Fundus photo taken with a portable handheld camera:
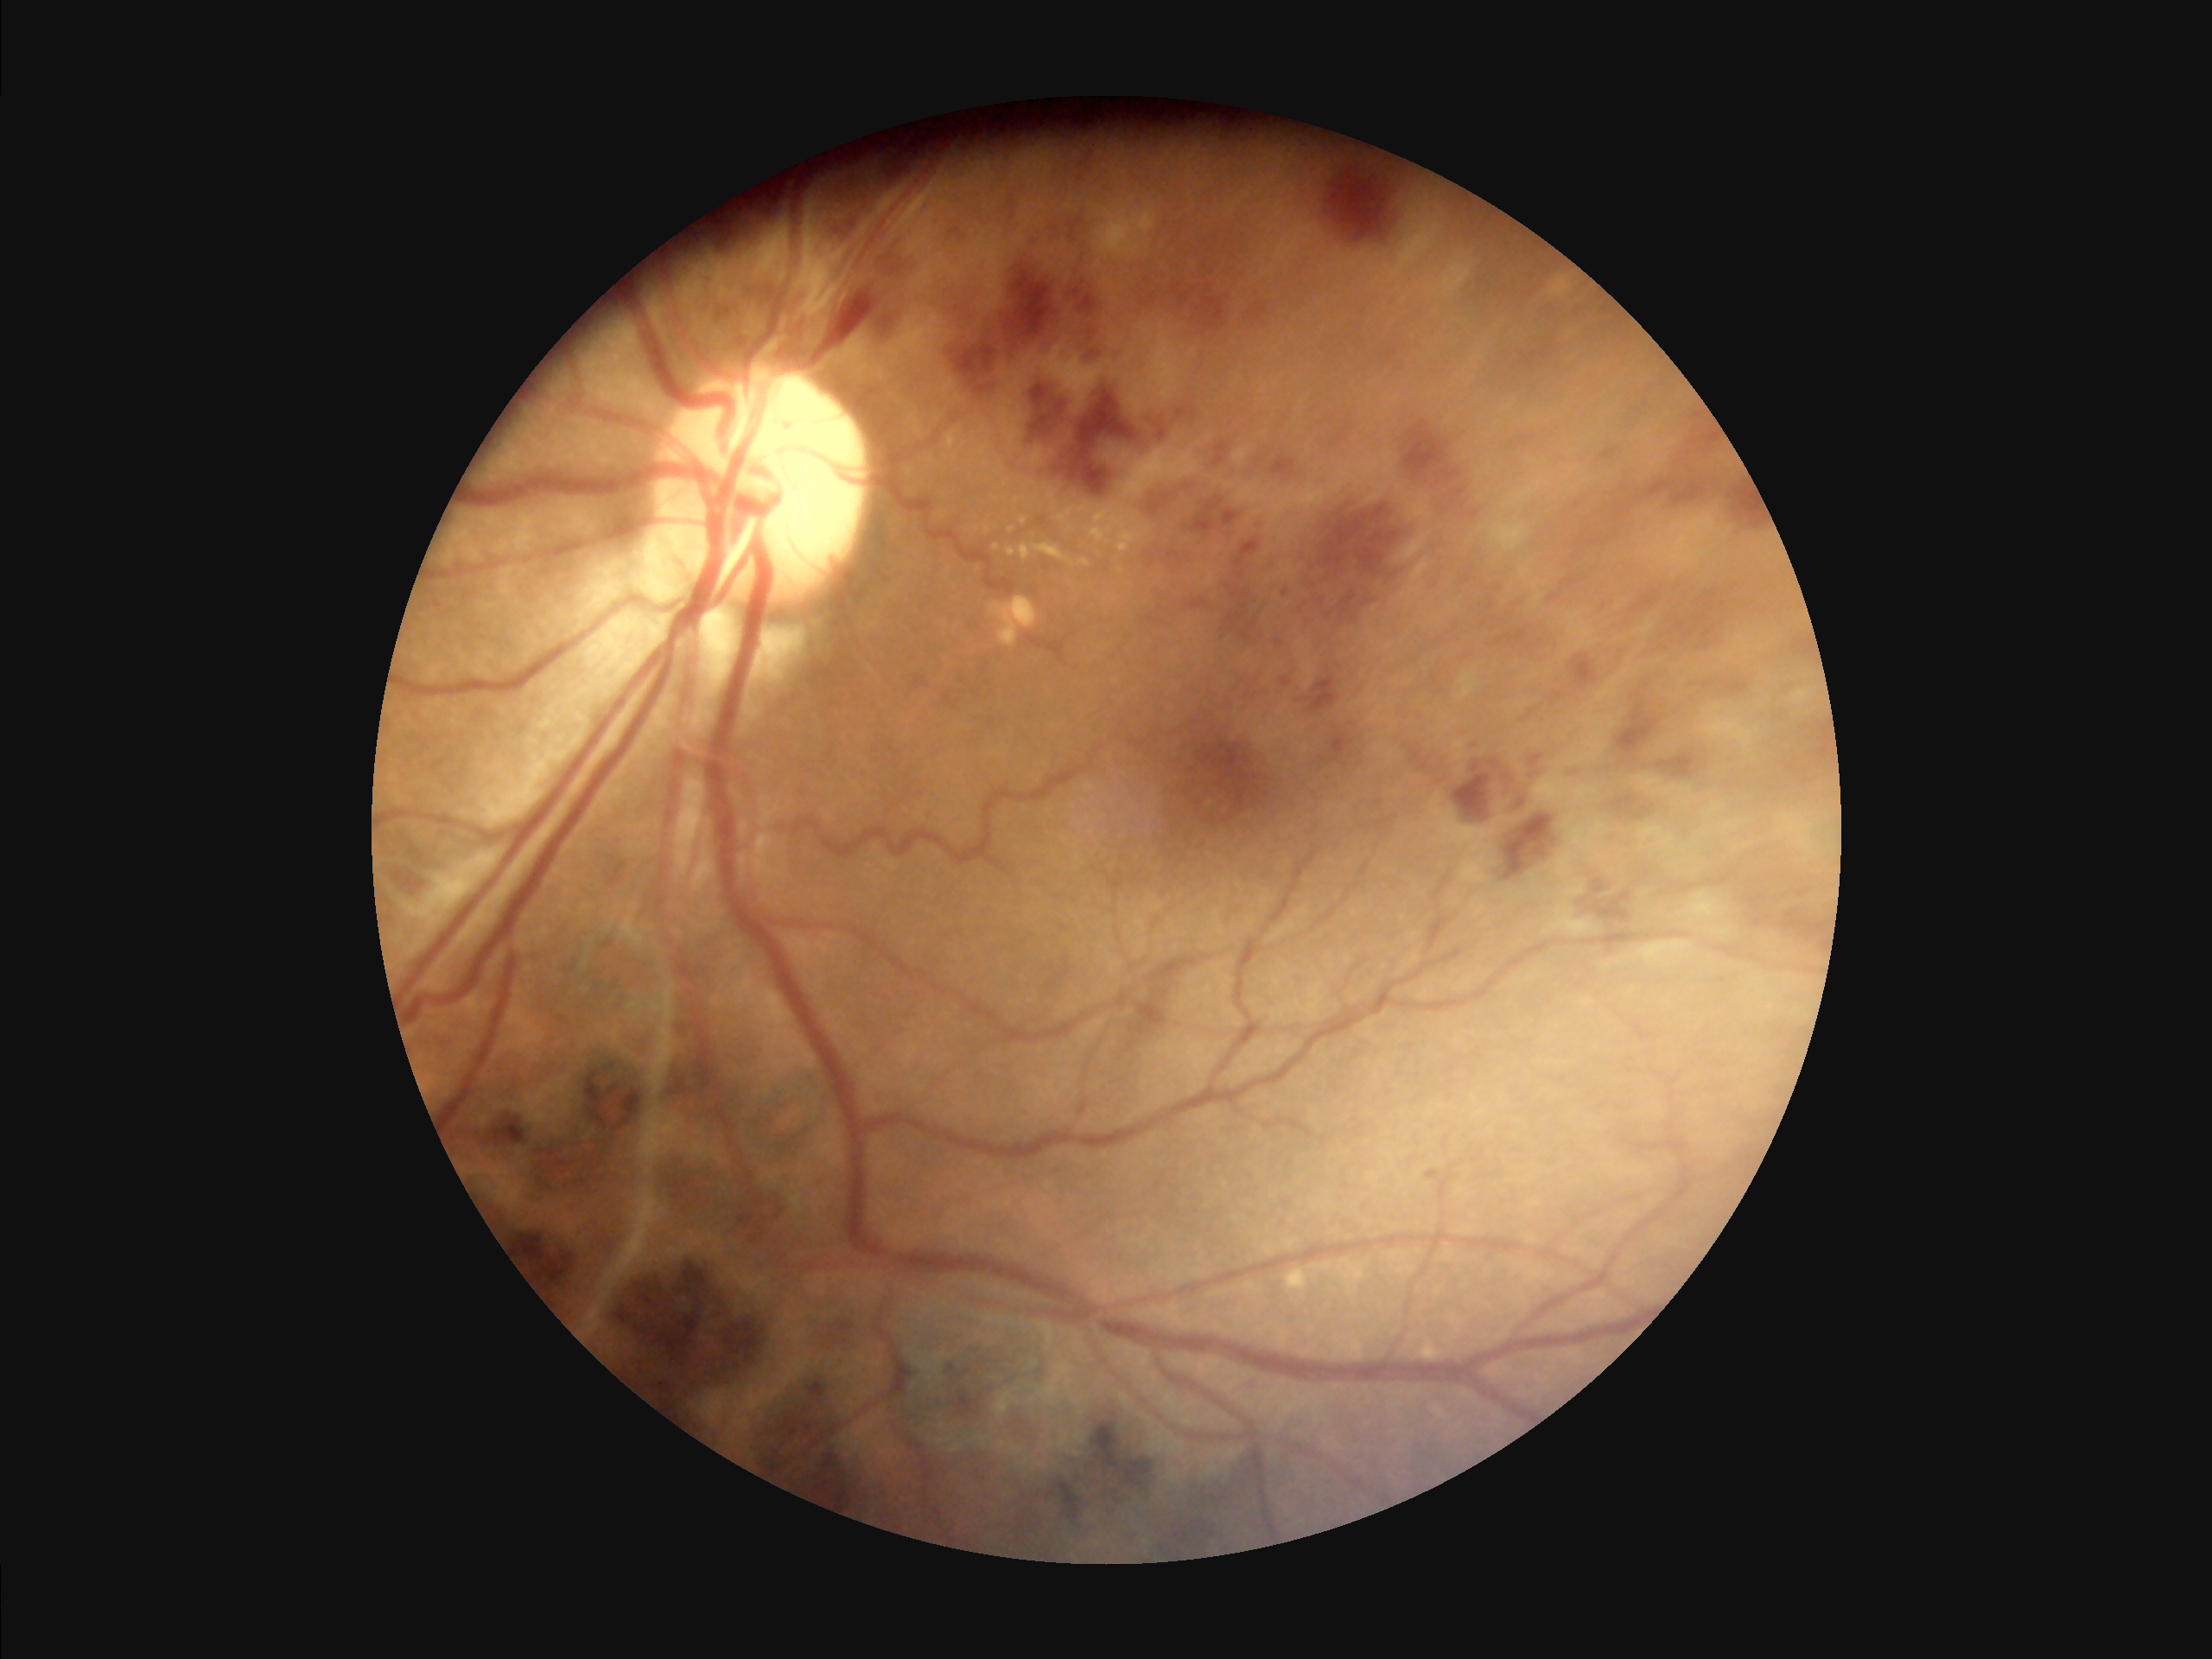

Image quality:
- overall: adequate
- illumination/color: good
- sharpness: clear
- contrast: good